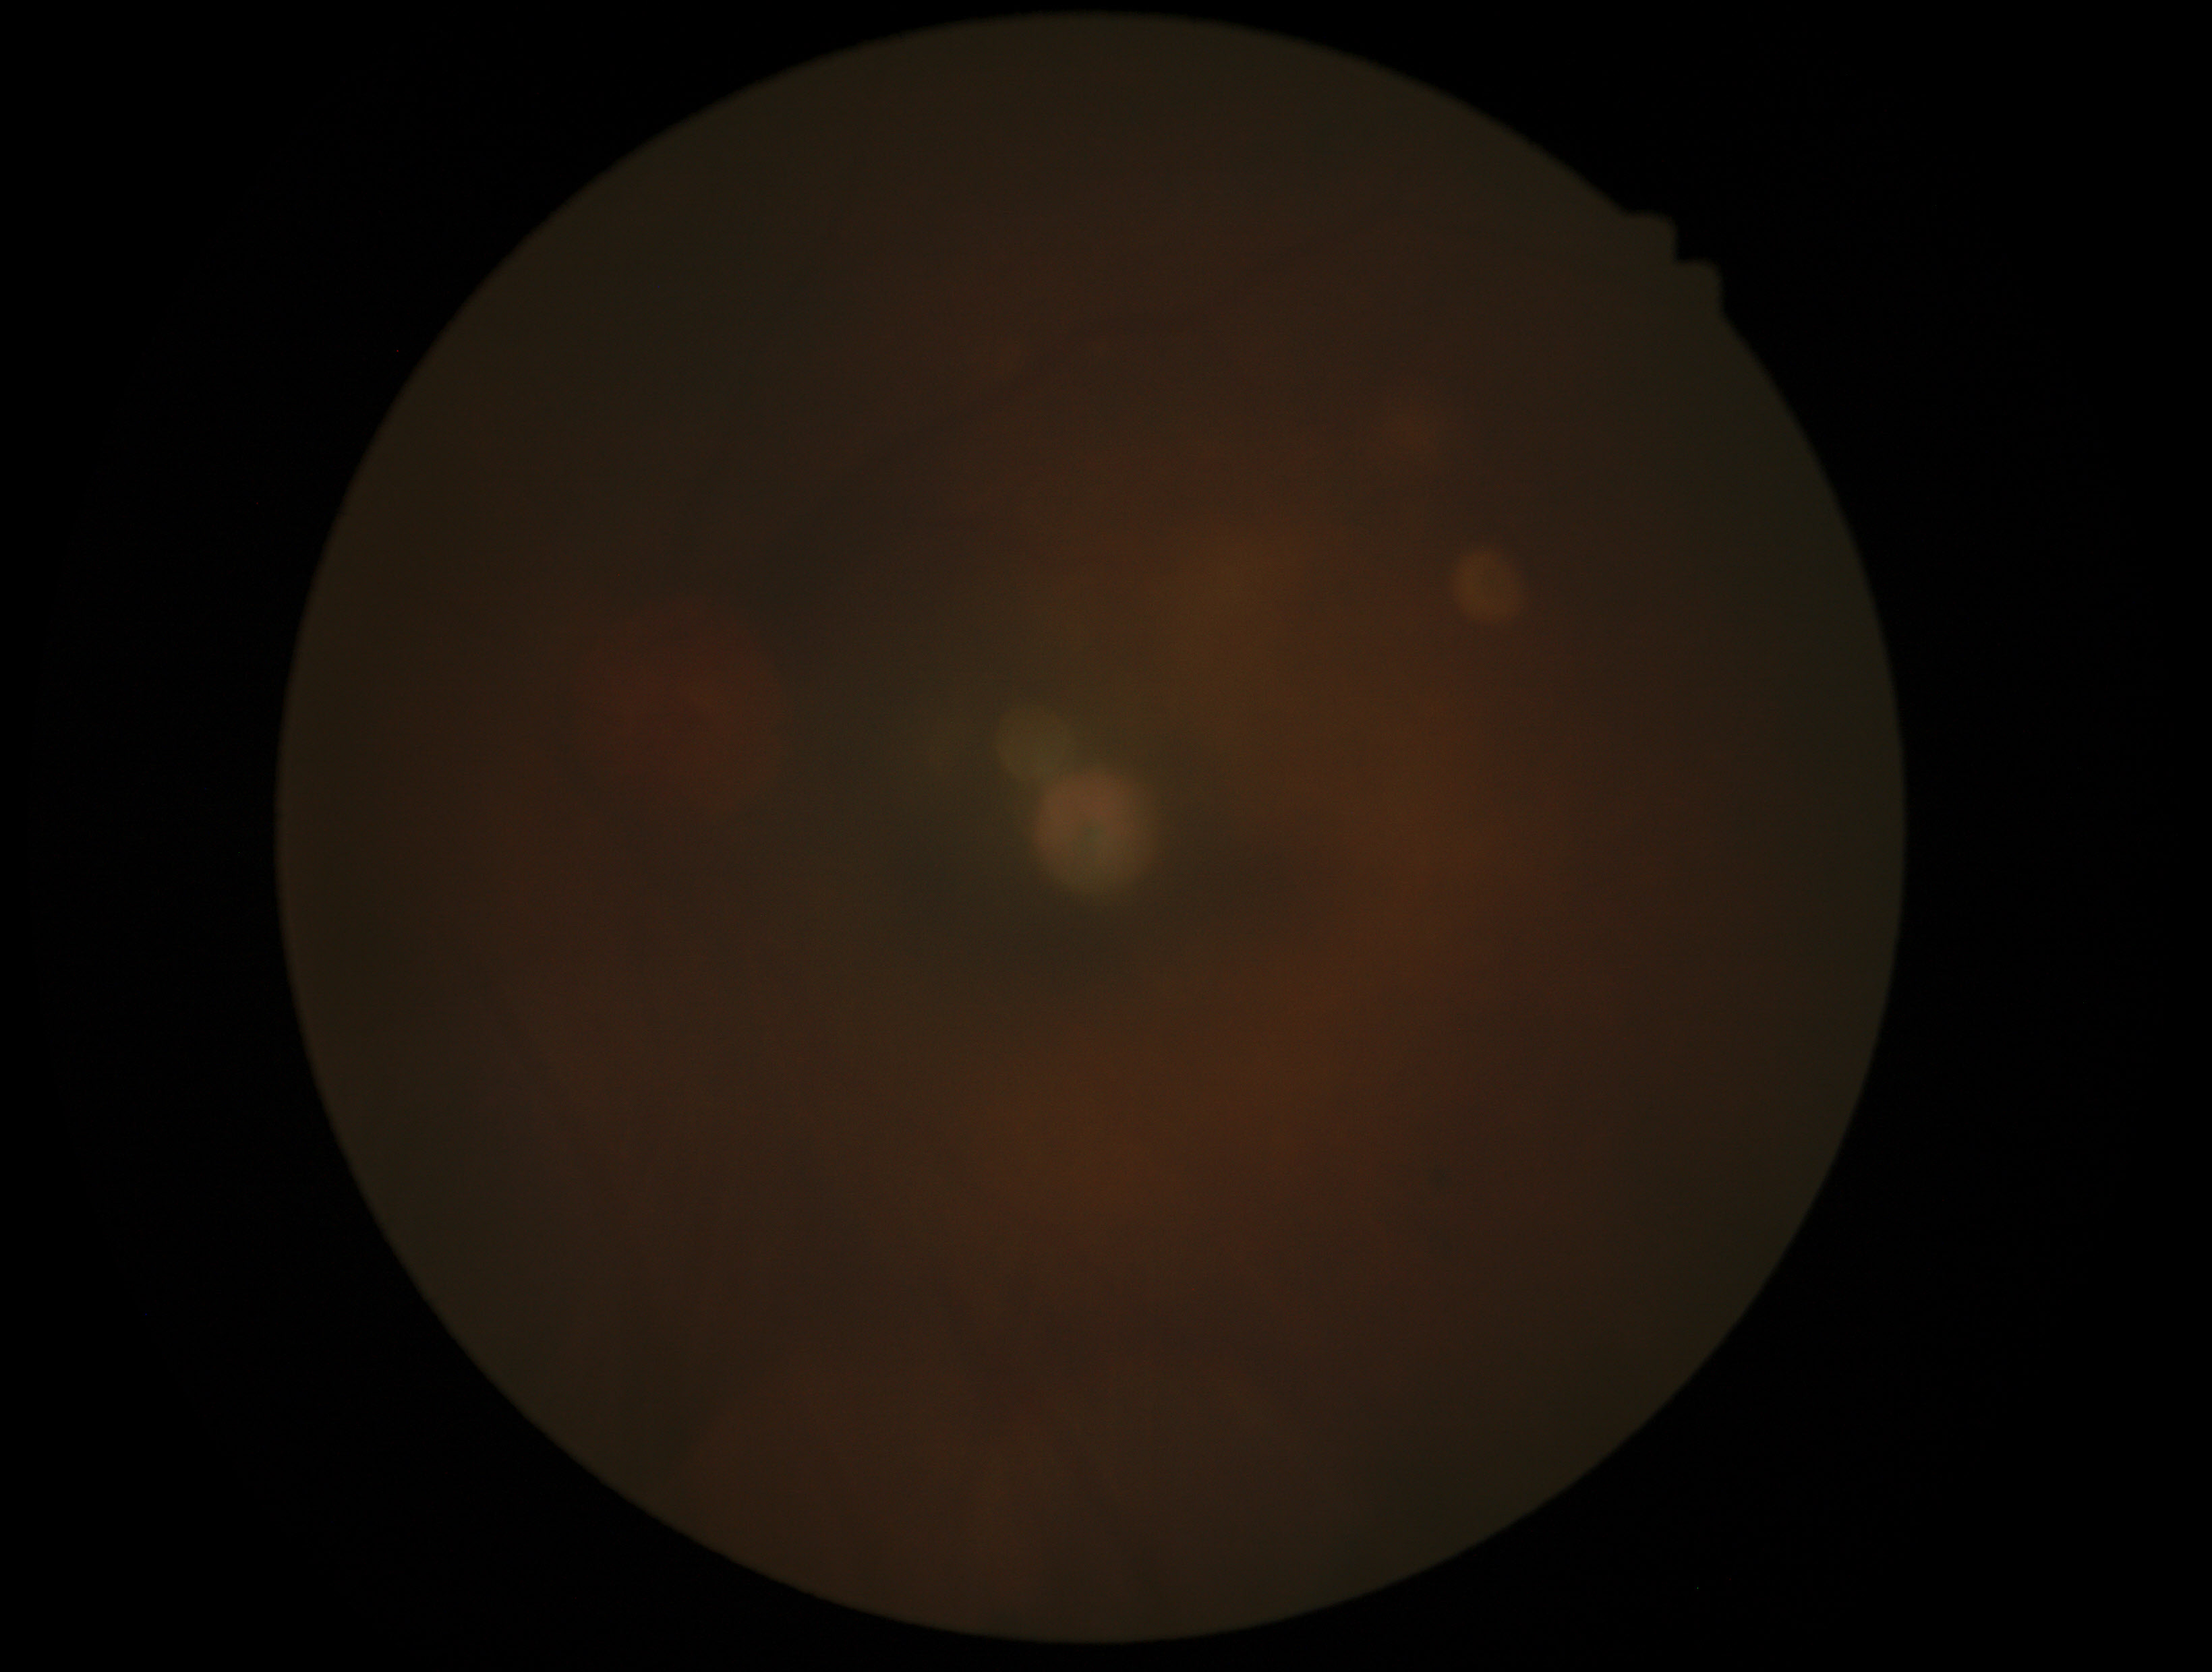 DR grade: ungradable due to poor image quality.